Pediatric retinal photograph (wide-field): 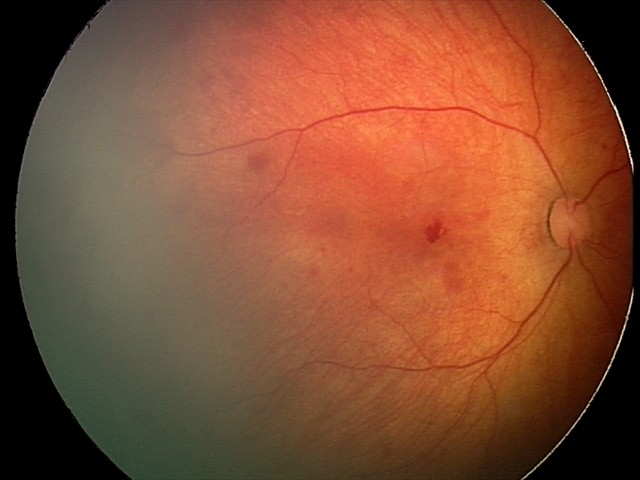
Examination diagnosed as retinal hemorrhages.